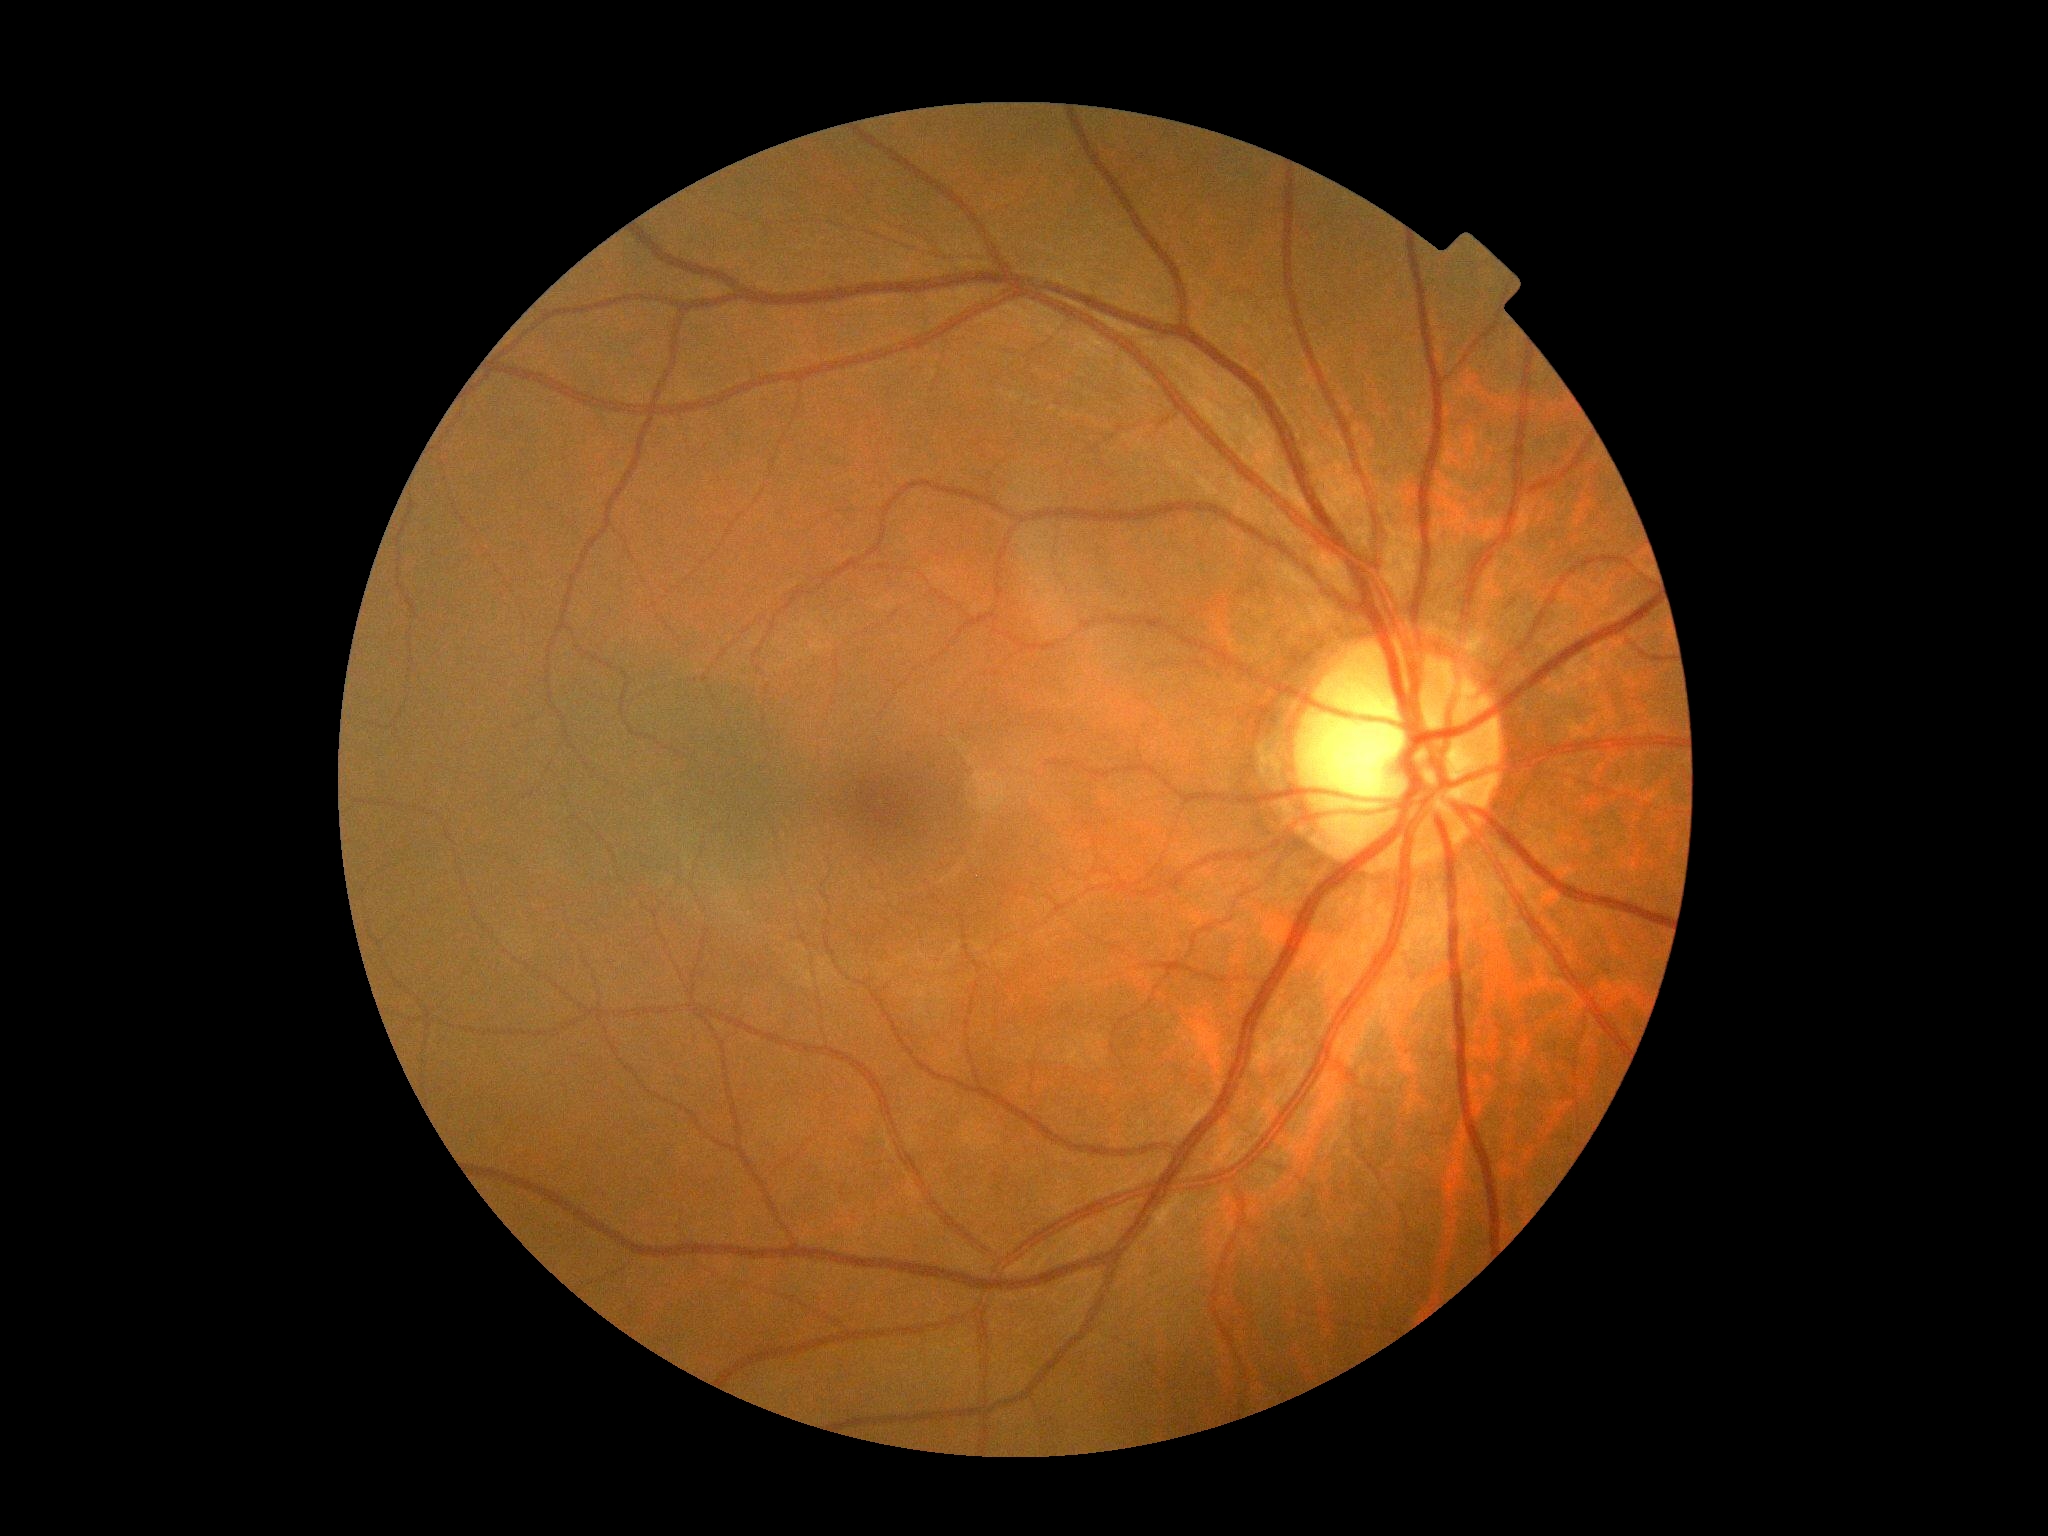

Retinopathy: grade 0 (no apparent retinopathy).